Color fundus image — 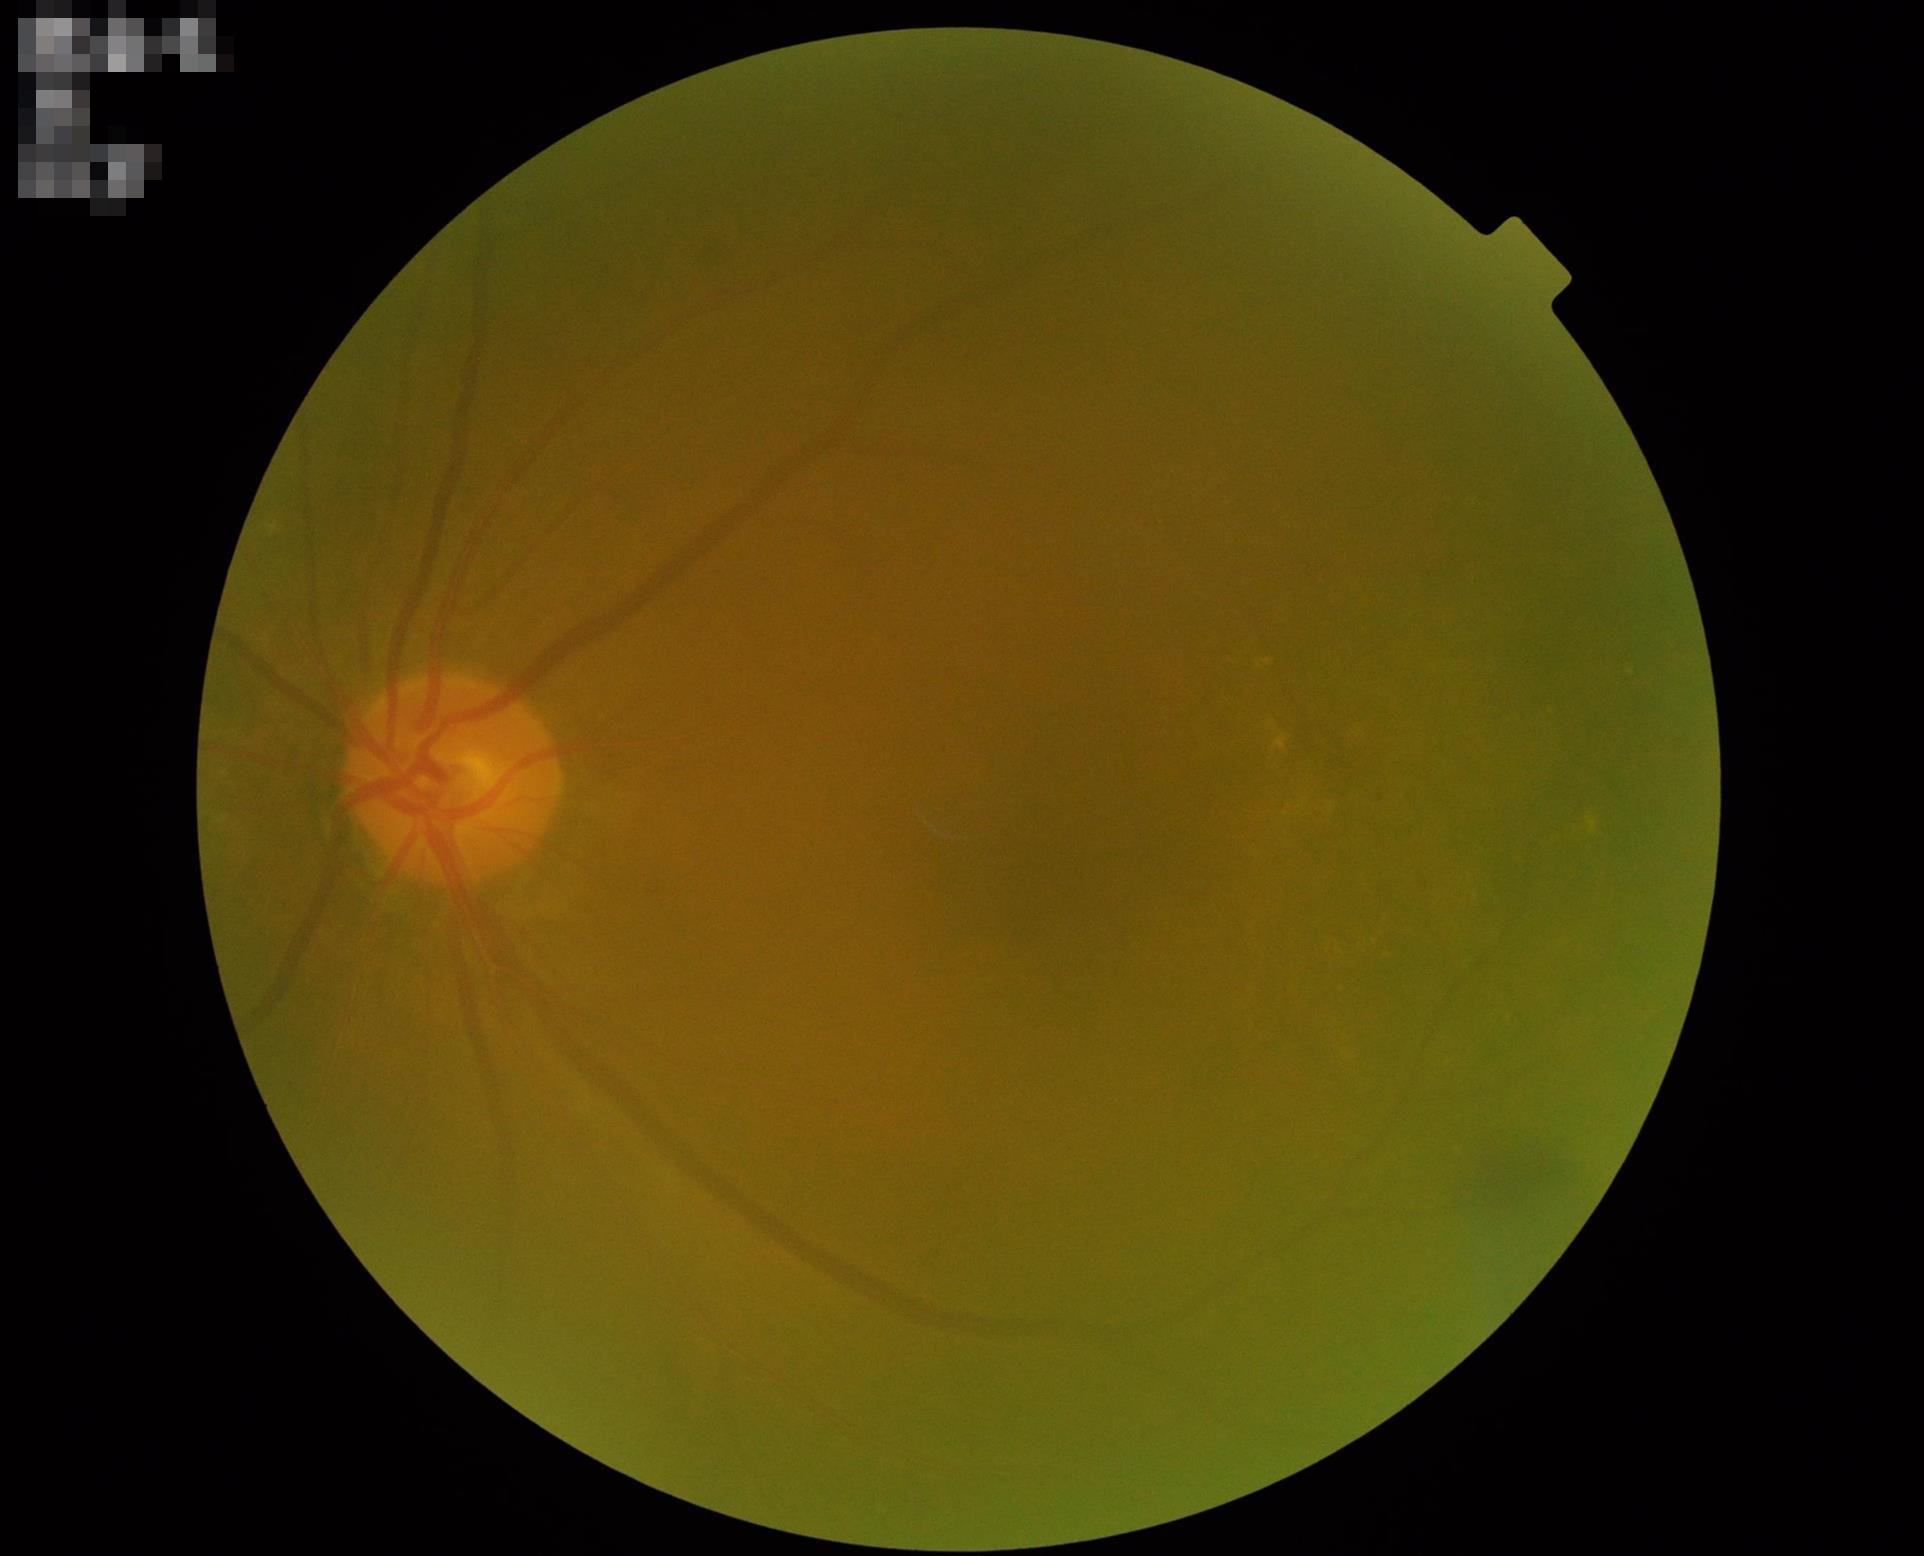

Overall quality = low; Illumination = poor; Contrast = reduced; Sharpness = reduced.